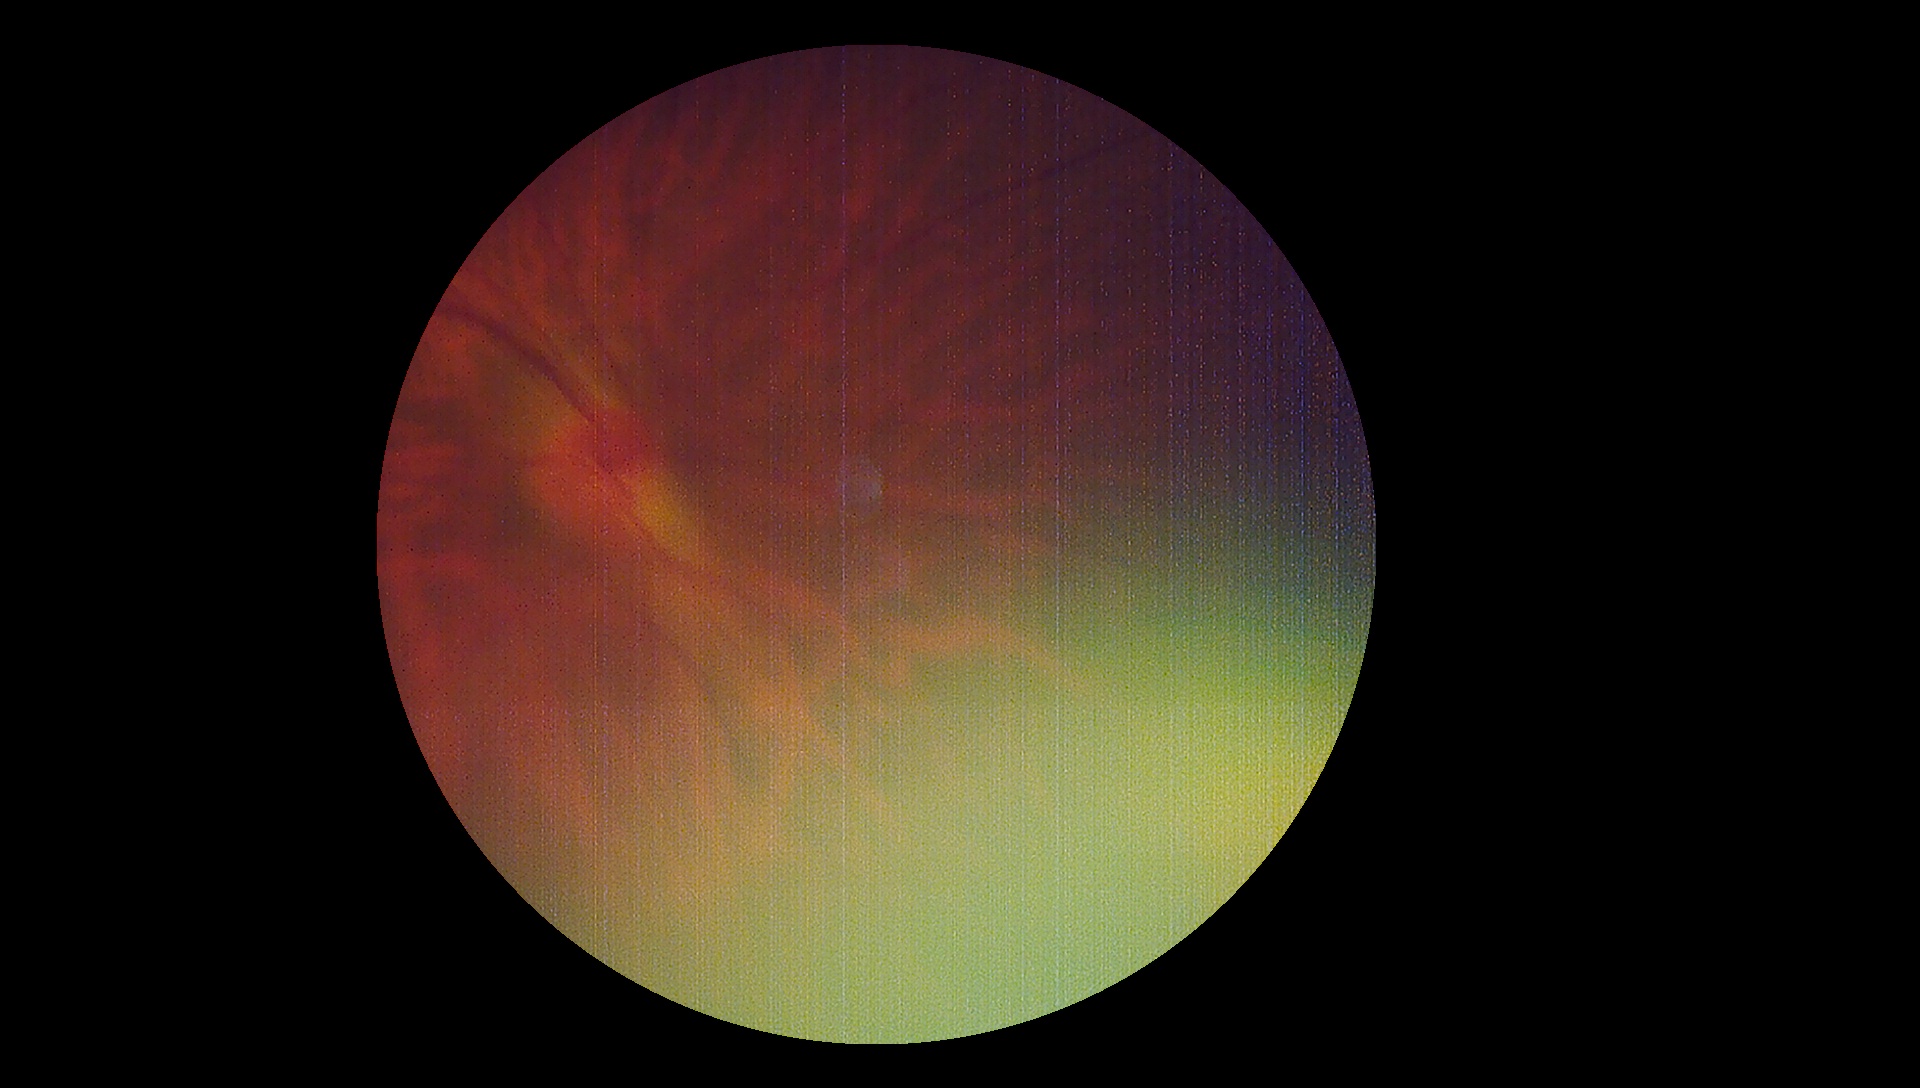
  dr_grade: ungradable due to poor image quality
  quality: insufficient